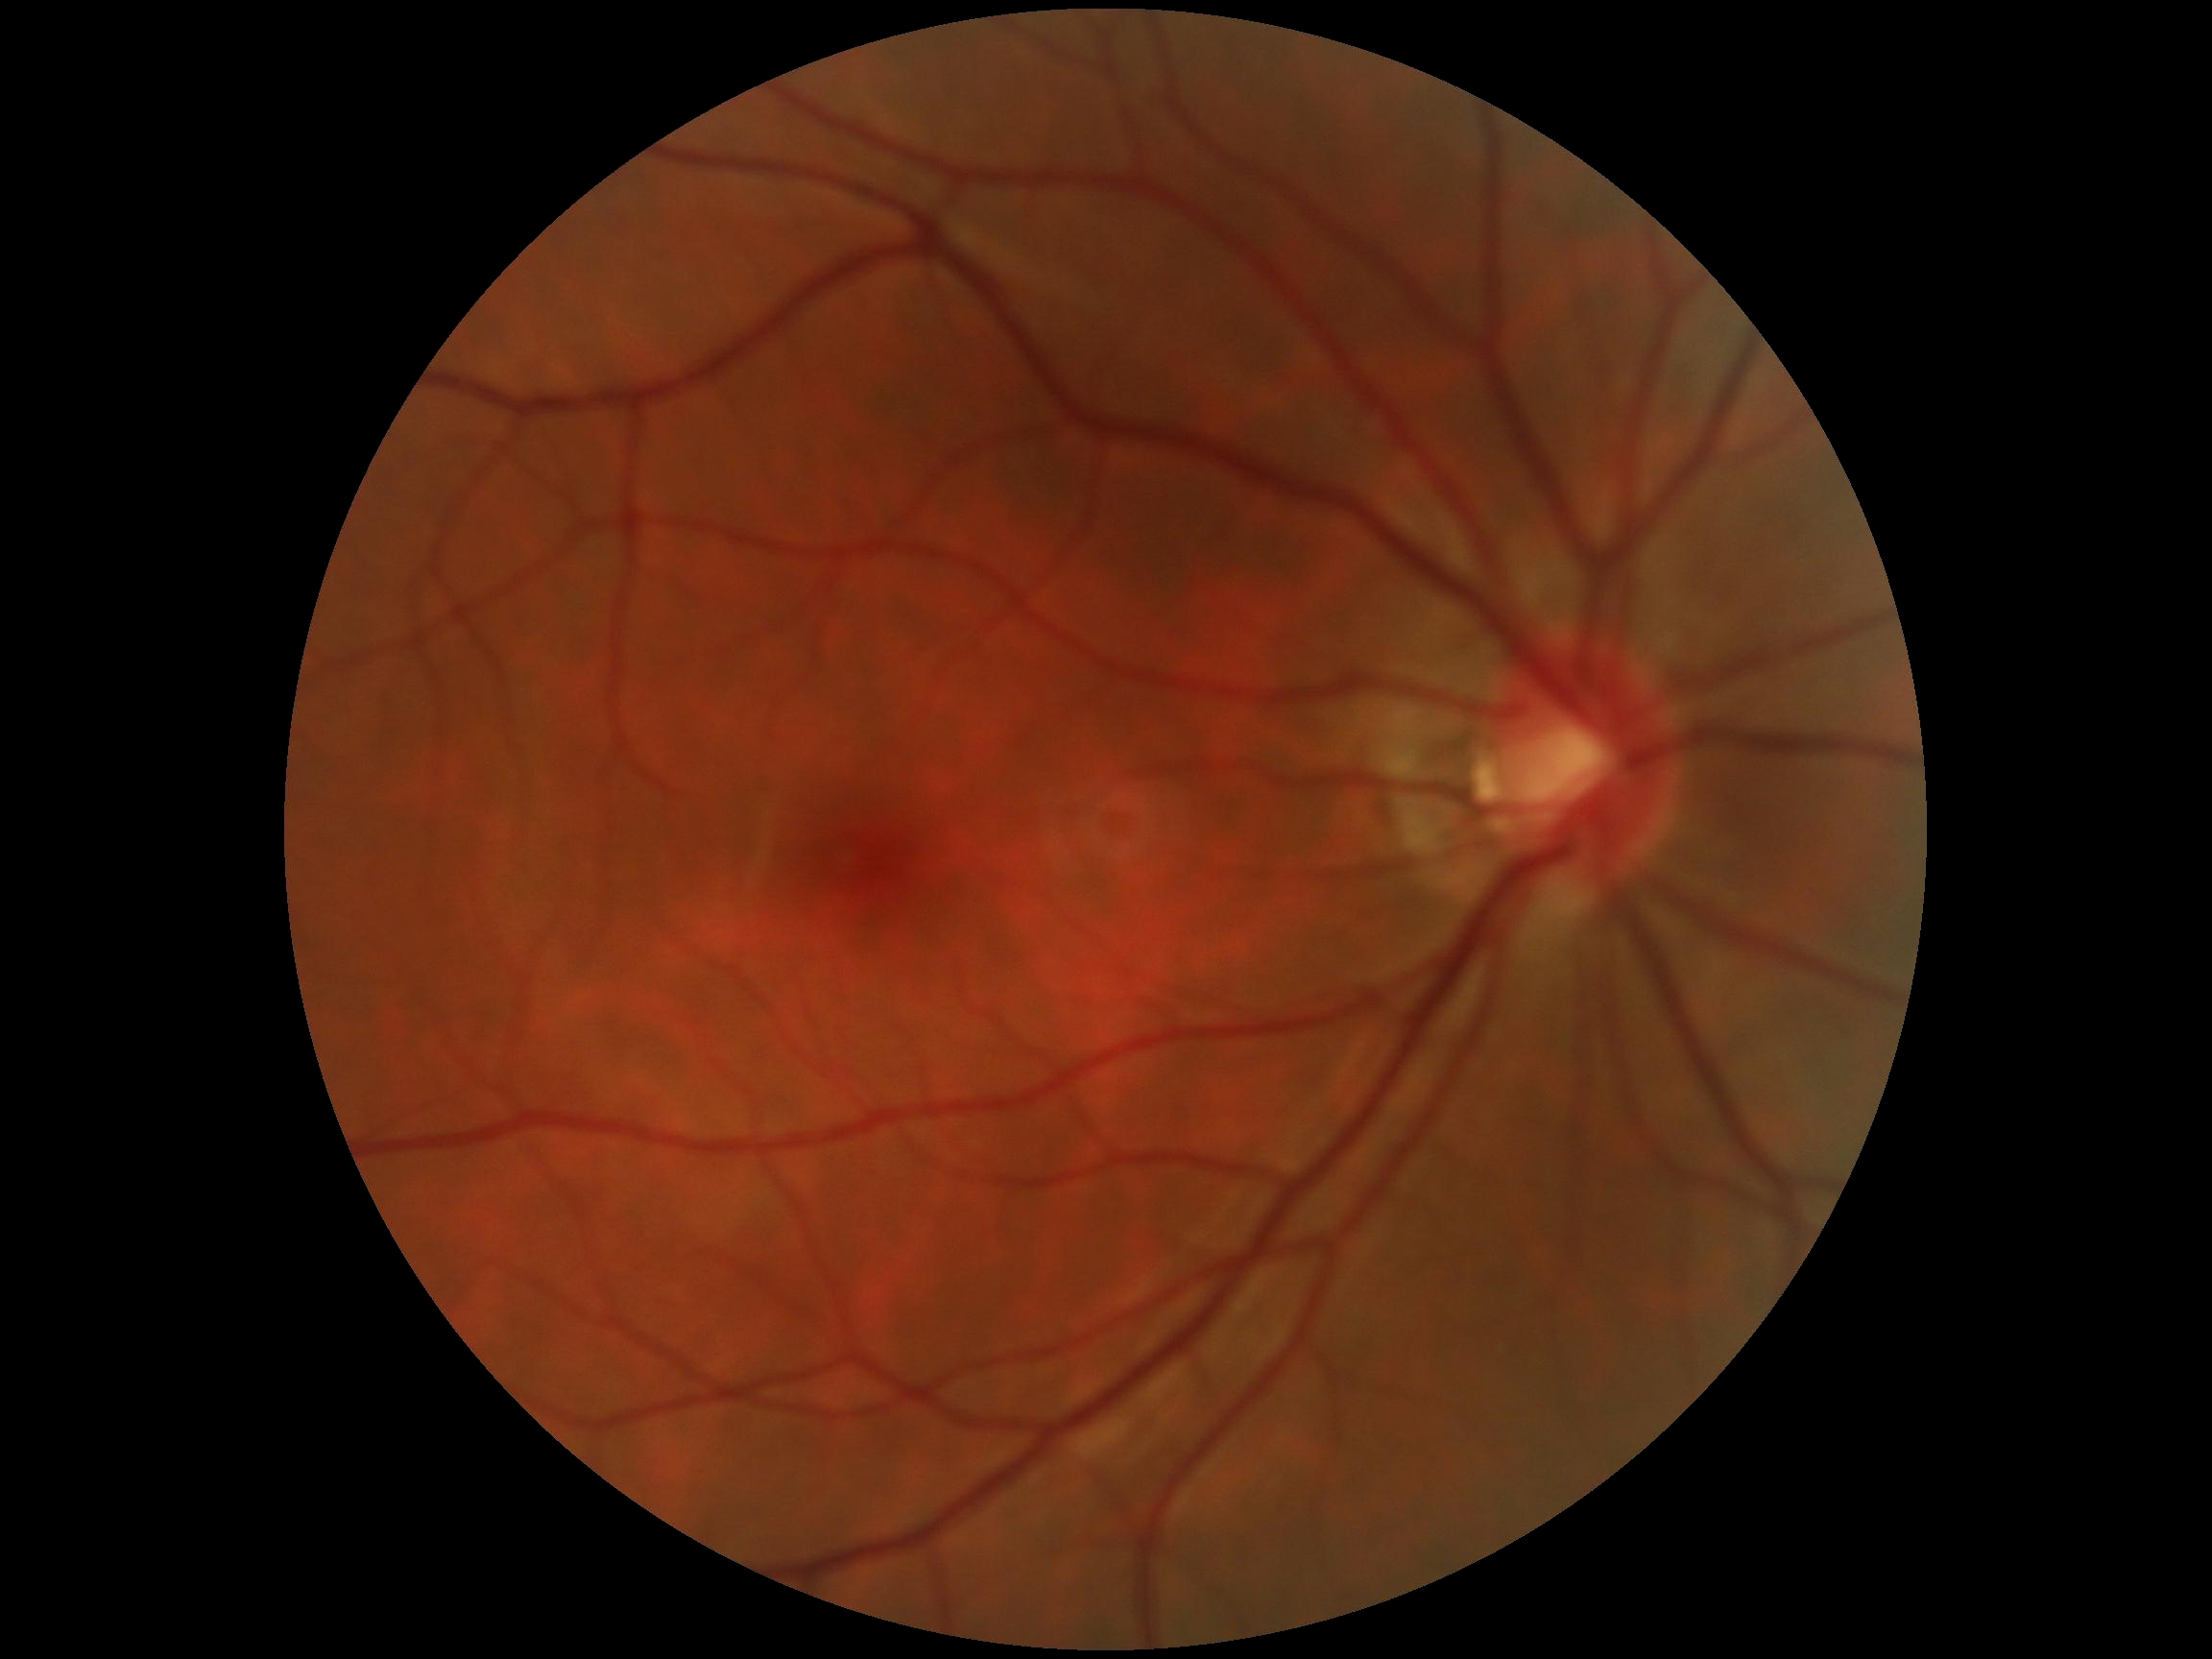
DR stage is no apparent retinopathy (grade 0).